Captured on a Remidio FOP fundus camera — 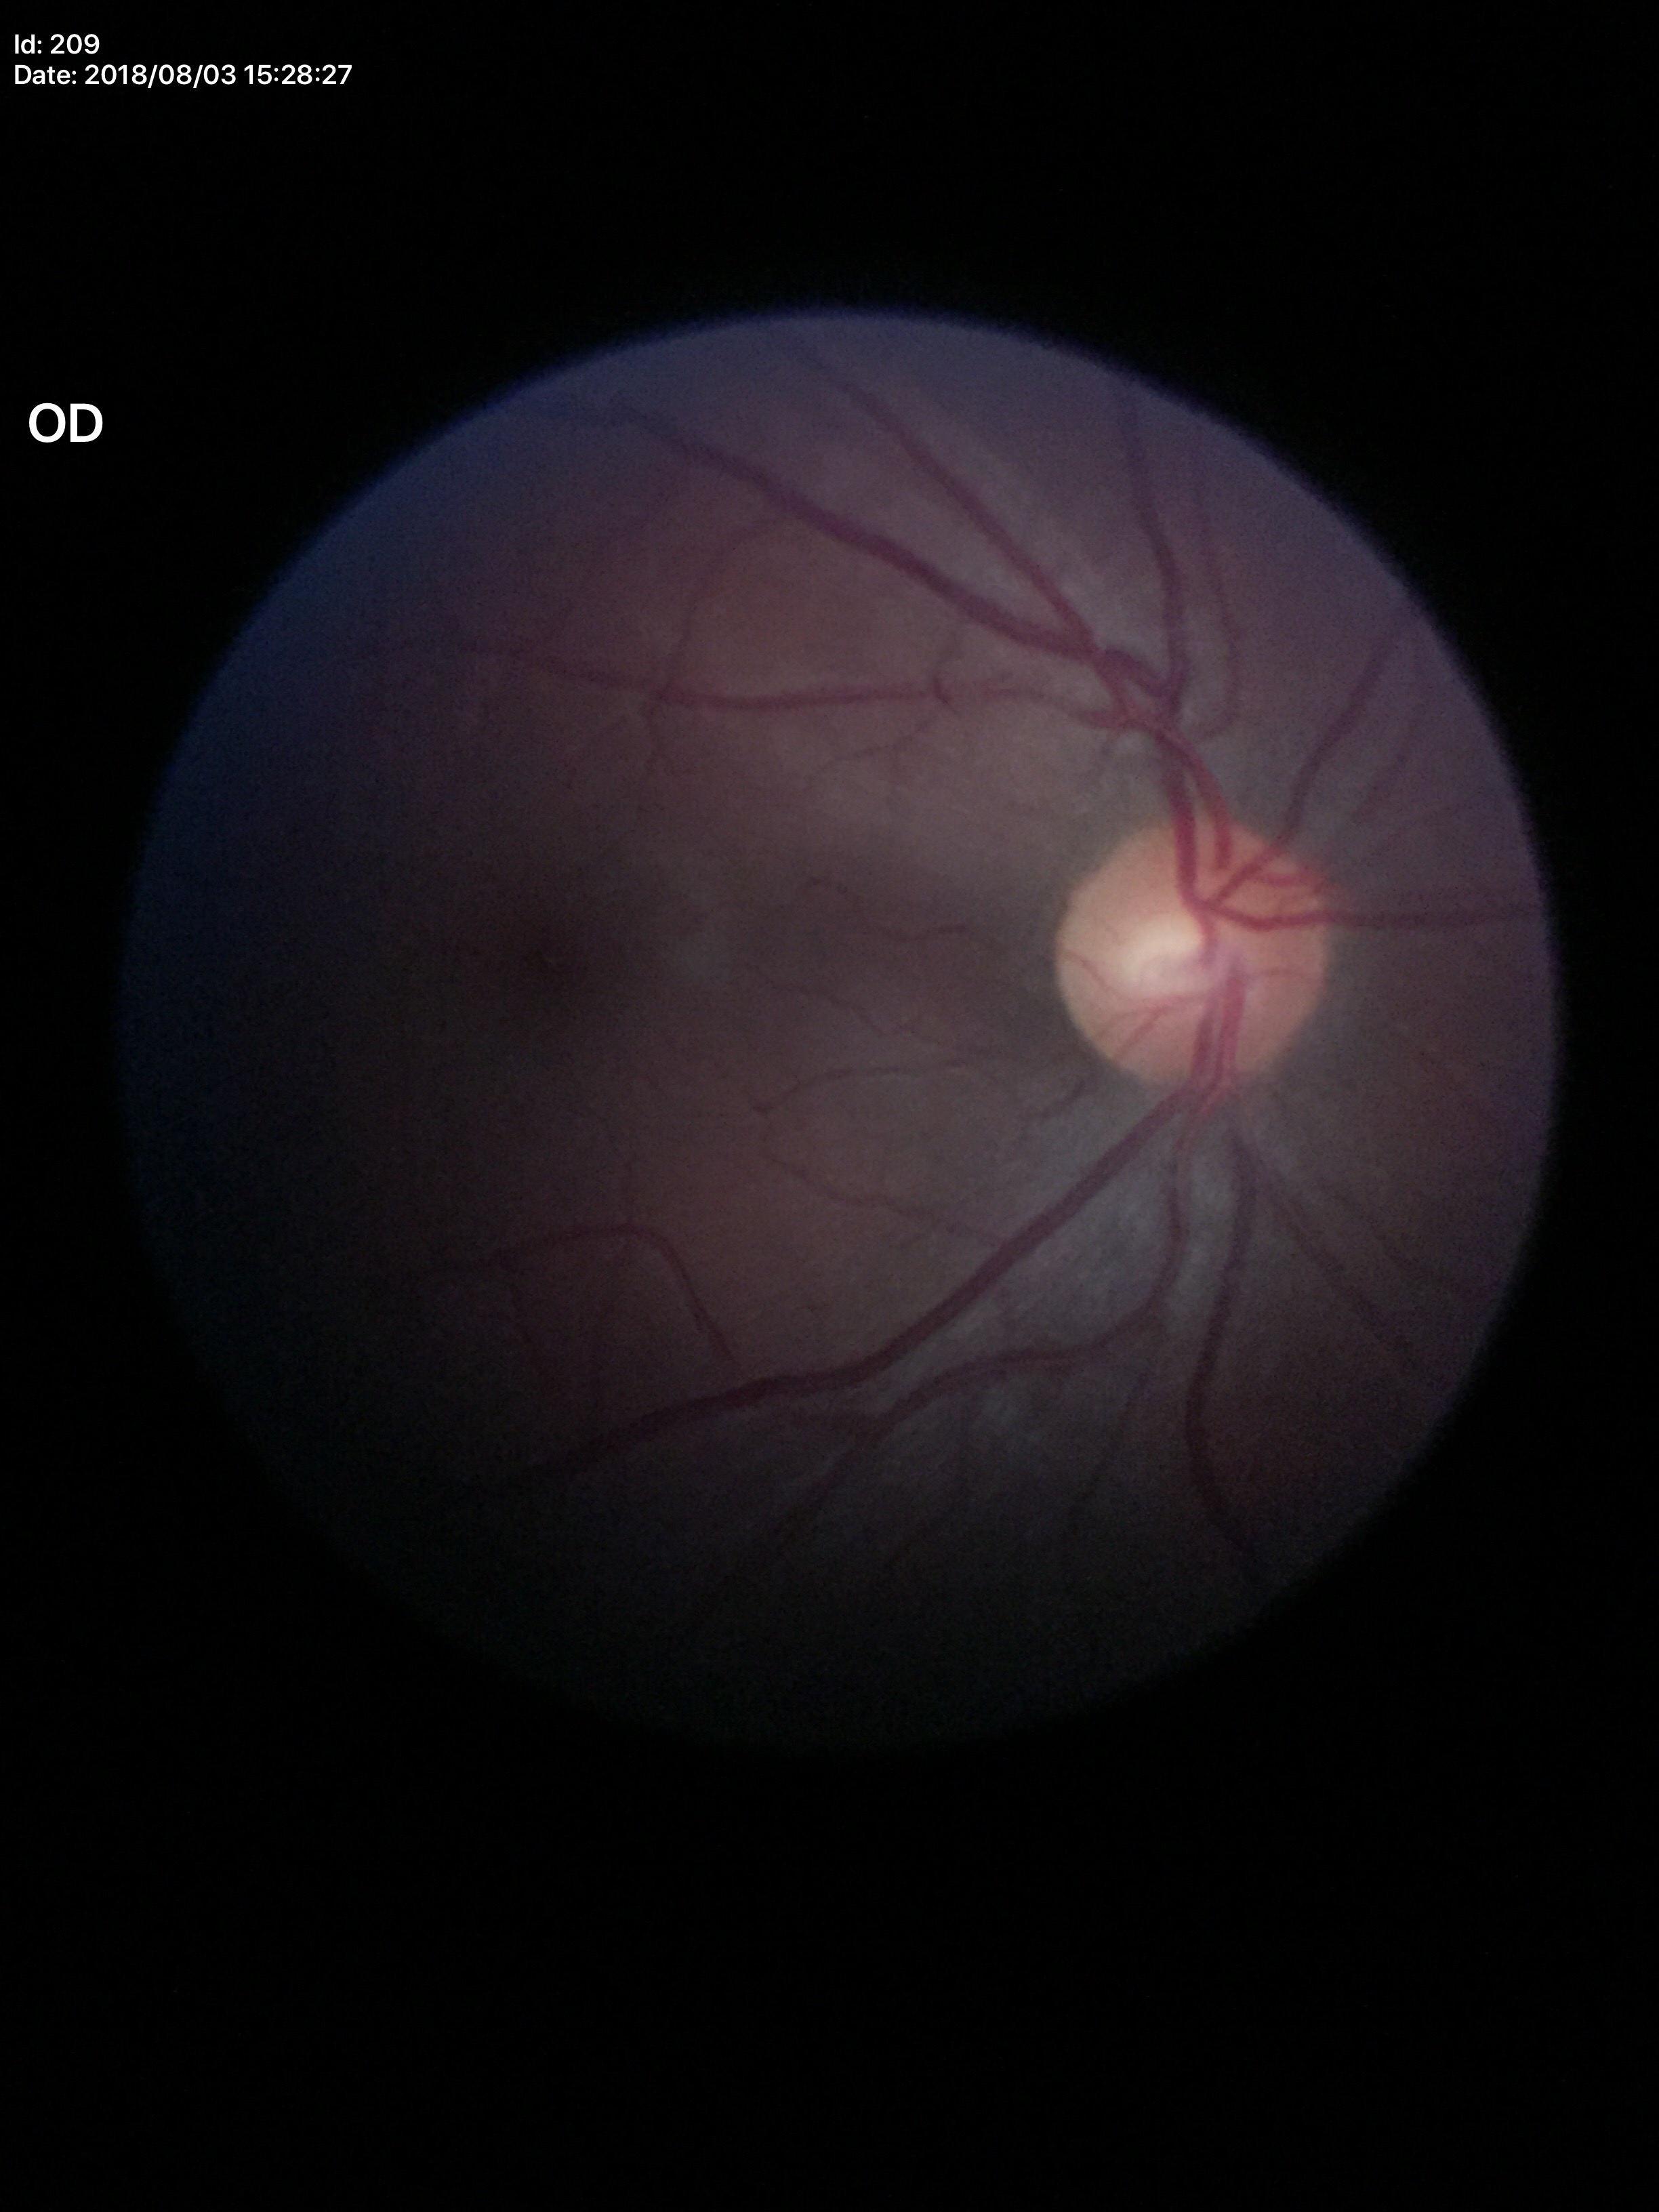 Vertical cup-disc ratio (VCDR) of 0.46. Glaucoma impression: no suspicious findings. Horizontal cup-disc ratio (HCDR) of 0.53.